Color fundus photograph, 1534 by 1534 pixels
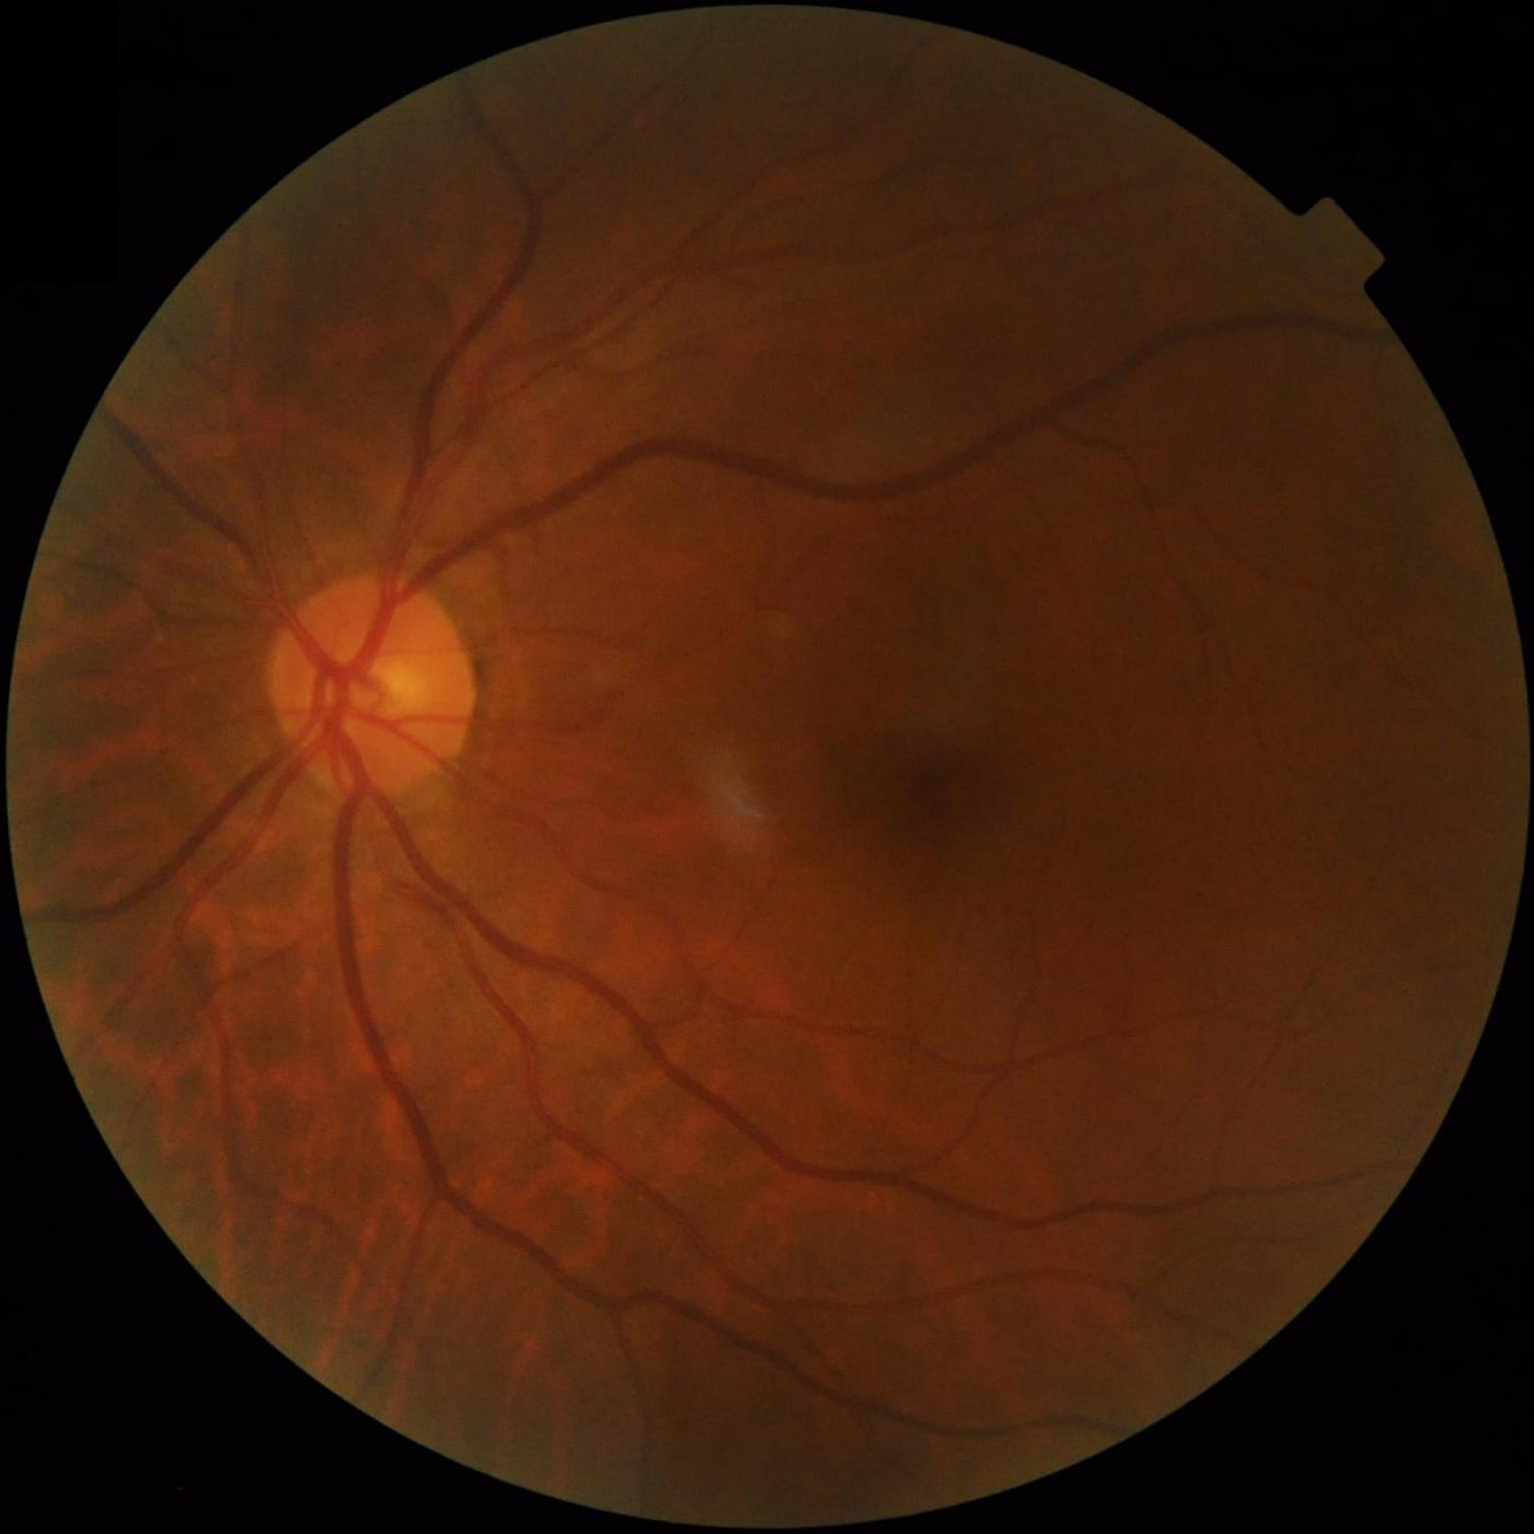

Contrast: satisfactory | Clarity: sharp | Illumination: adequate | Overall quality: satisfactory.